1504 x 1000 pixels. Fundus photo: 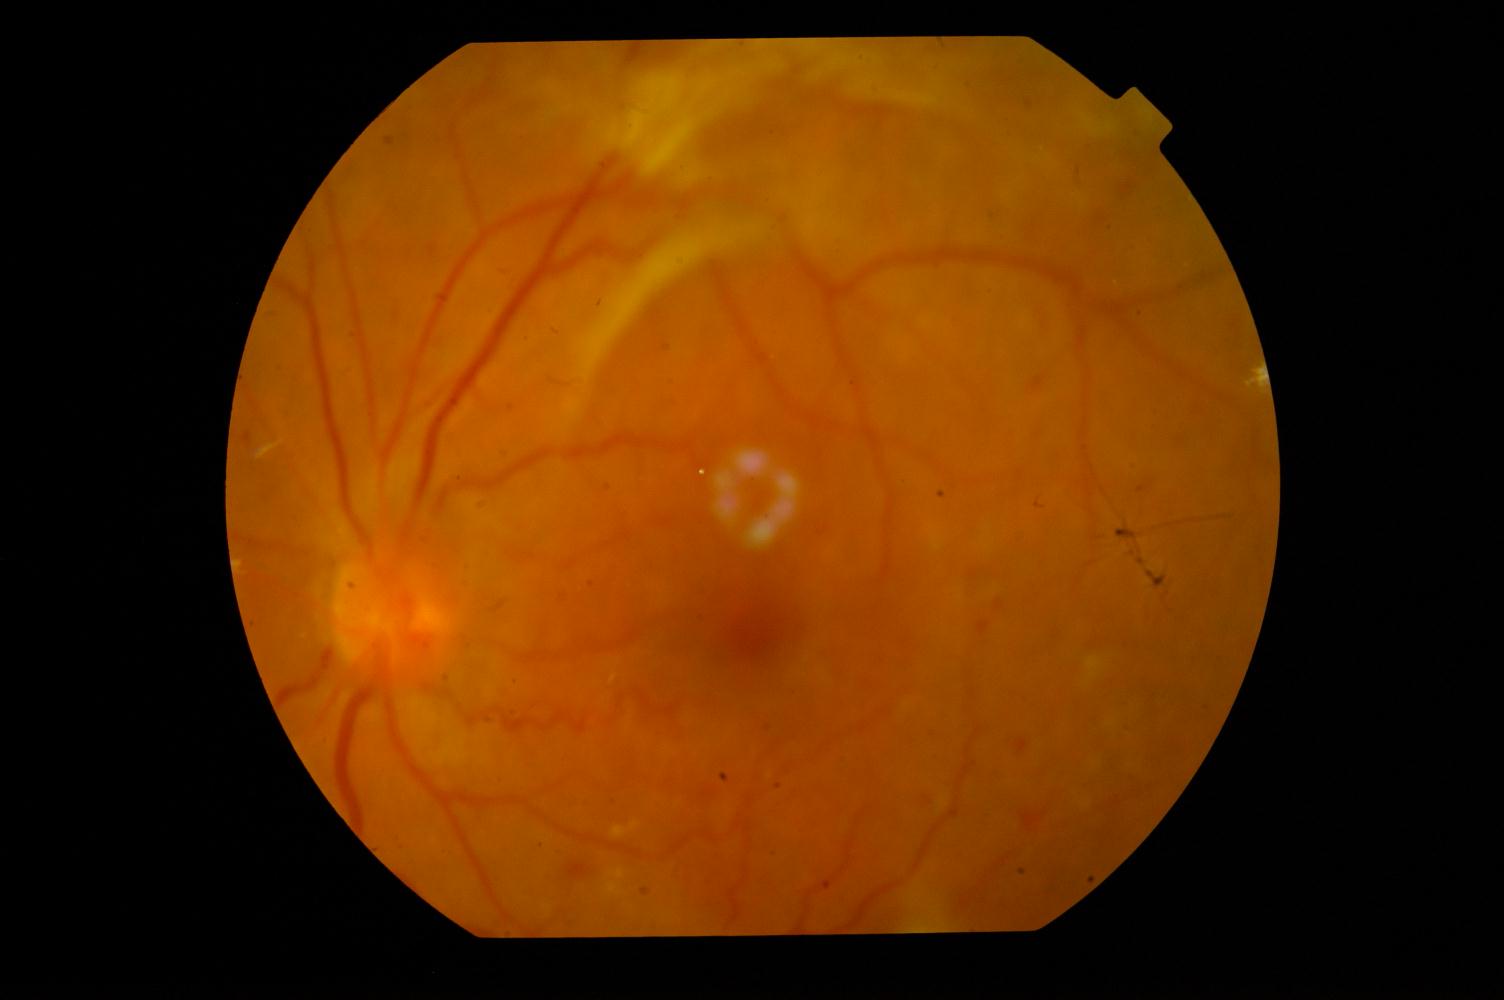
Pathology: DR (diabetic retinopathy).